Color fundus image · nonmydriatic fundus photograph:
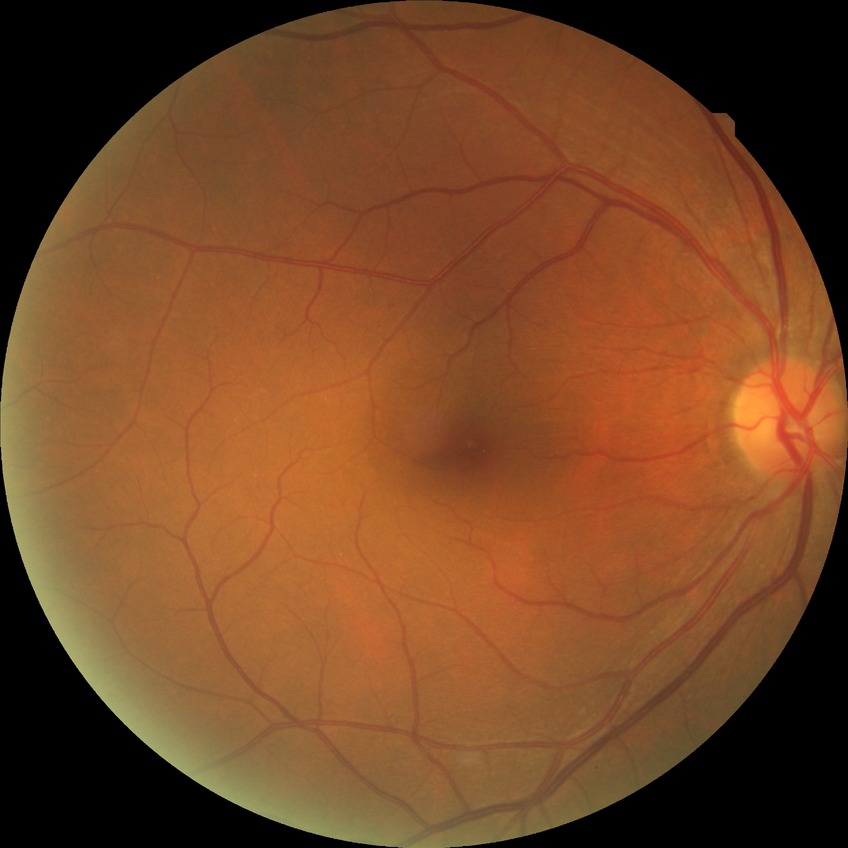 diabetic retinopathy (DR) = NDR (no diabetic retinopathy).